Captured with the Clarity RetCam 3 (130° field of view) · wide-field fundus photograph from neonatal ROP screening — 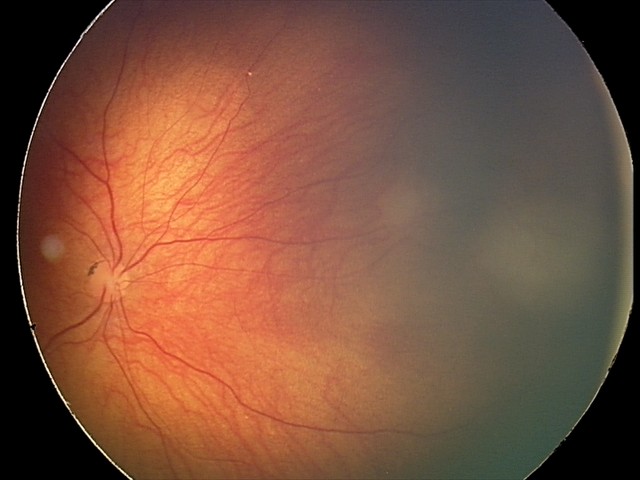

Diagnosis = retinal astrocytic hamartoma.